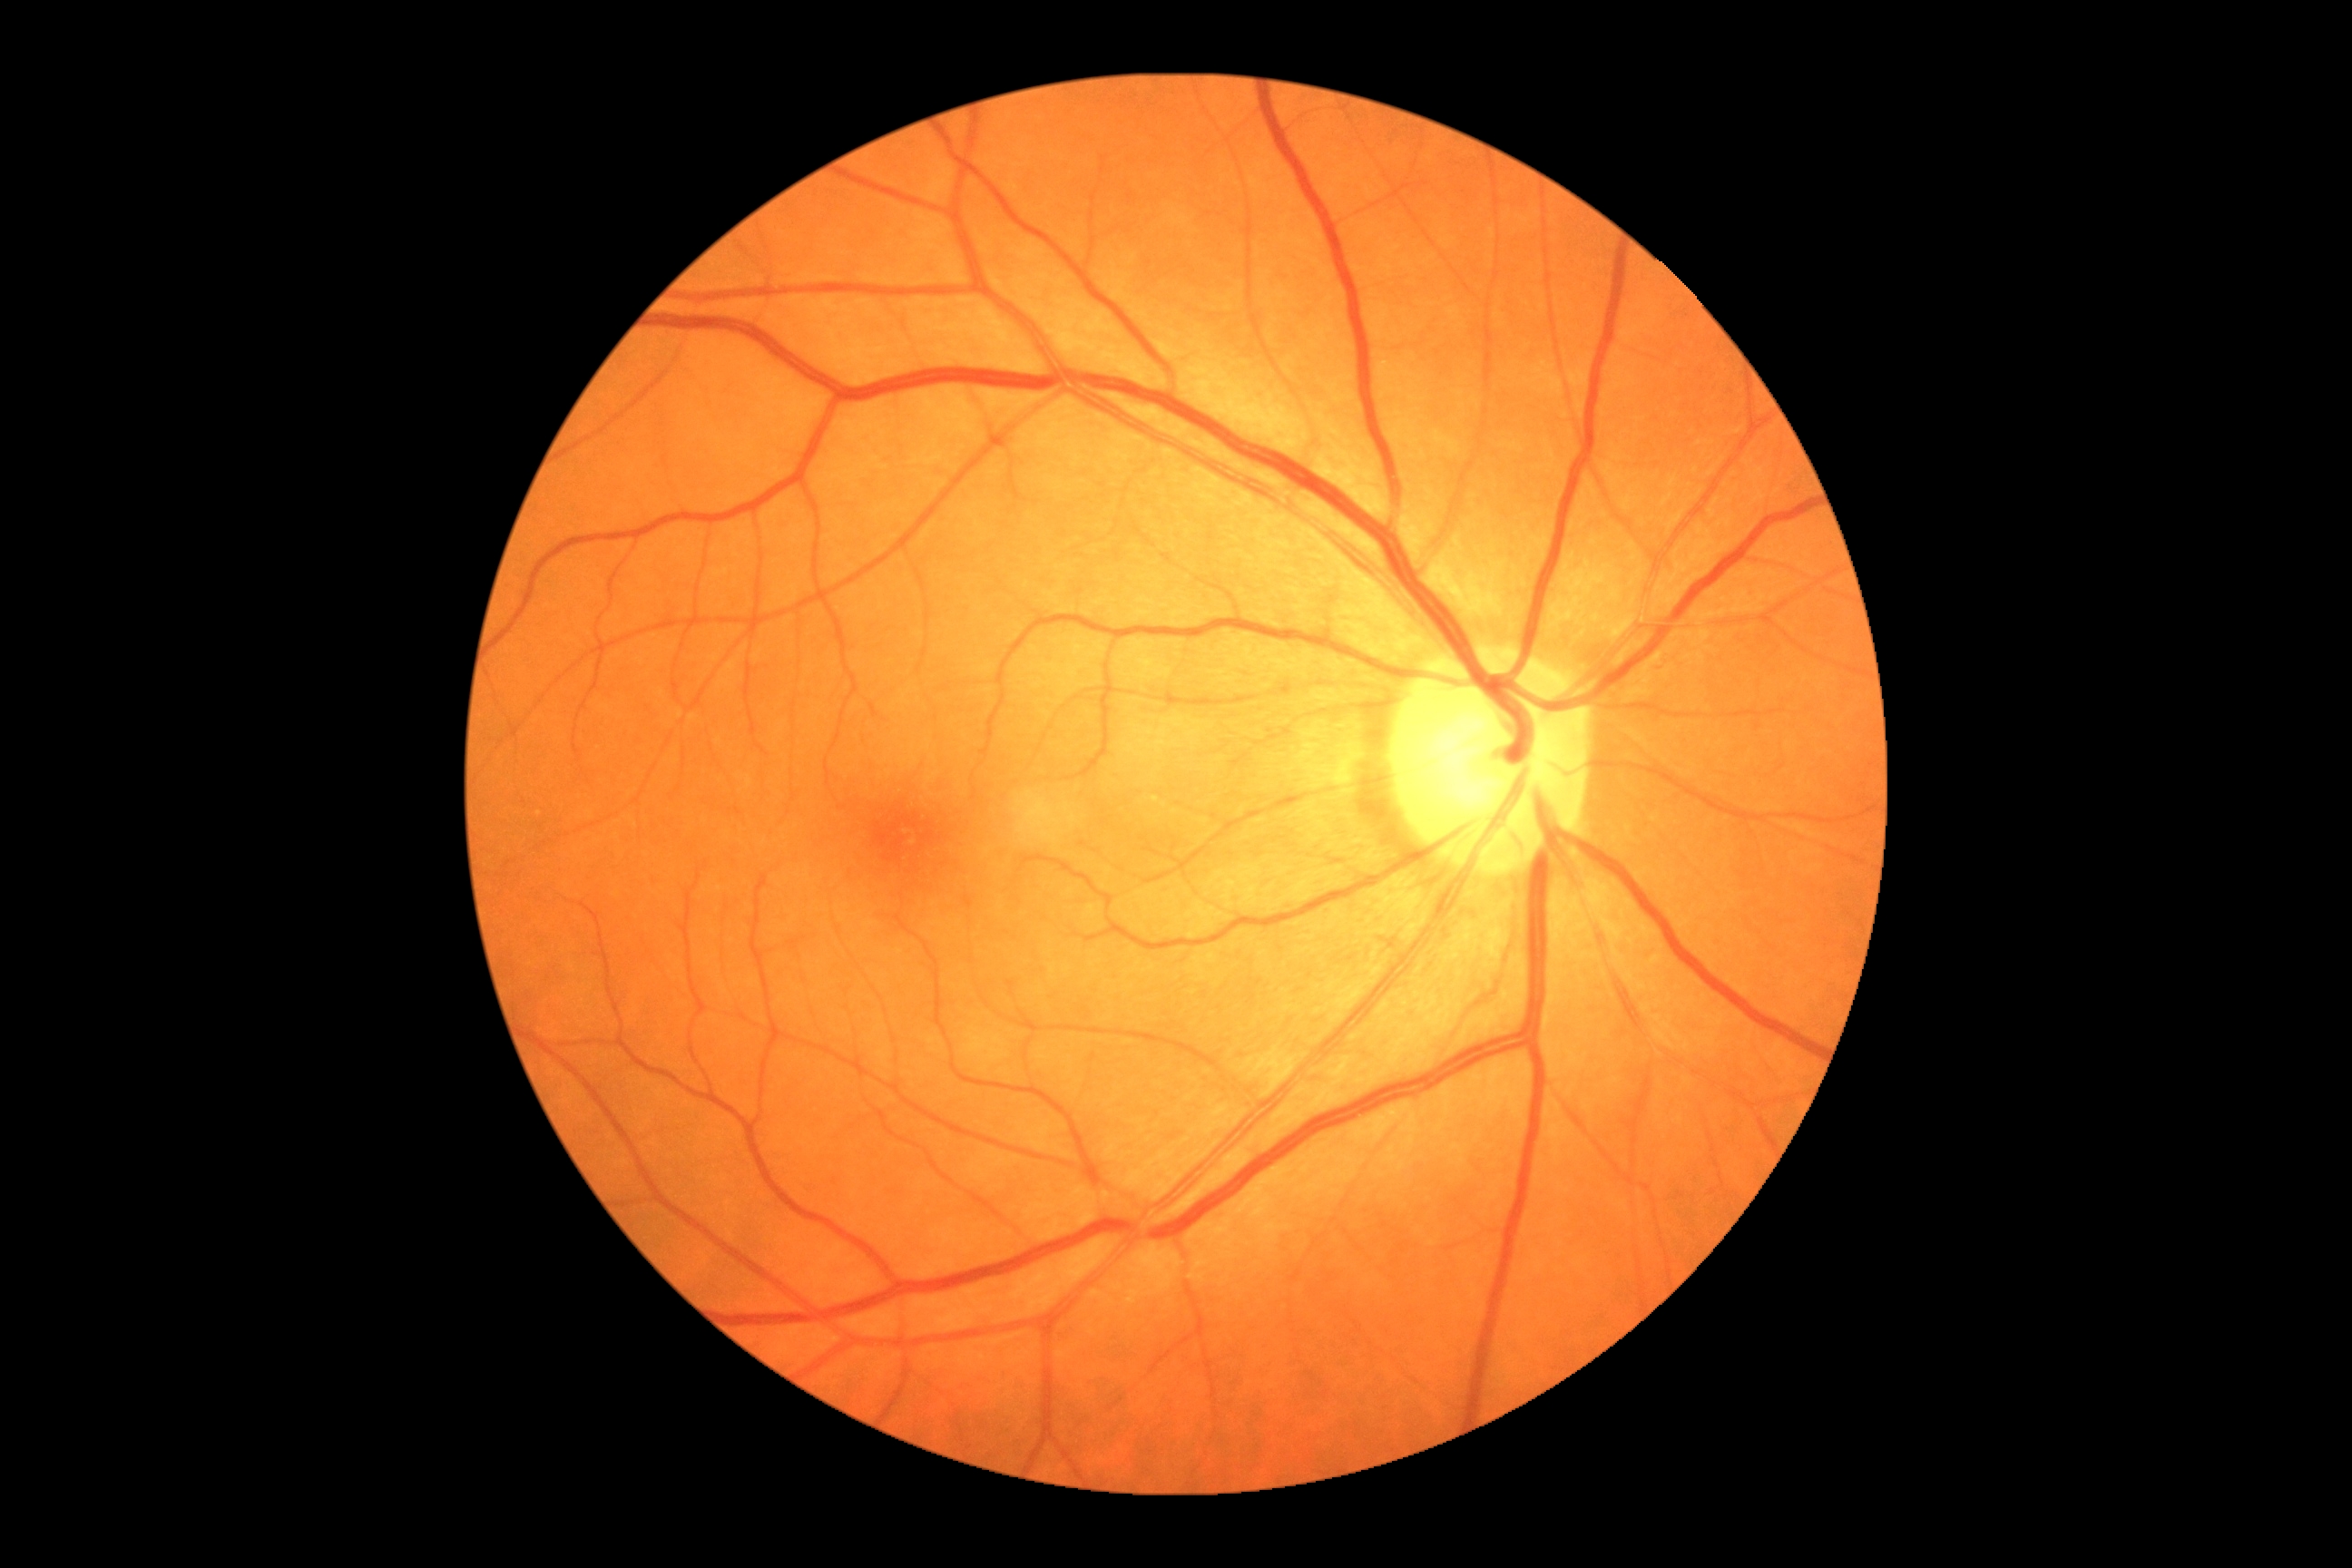 Findings:
• DR severity — 0/4